DR severity per modified Davis staging, retinal fundus photograph, NIDEK AFC-230, 848 by 848 pixels, 45 degree fundus photograph:
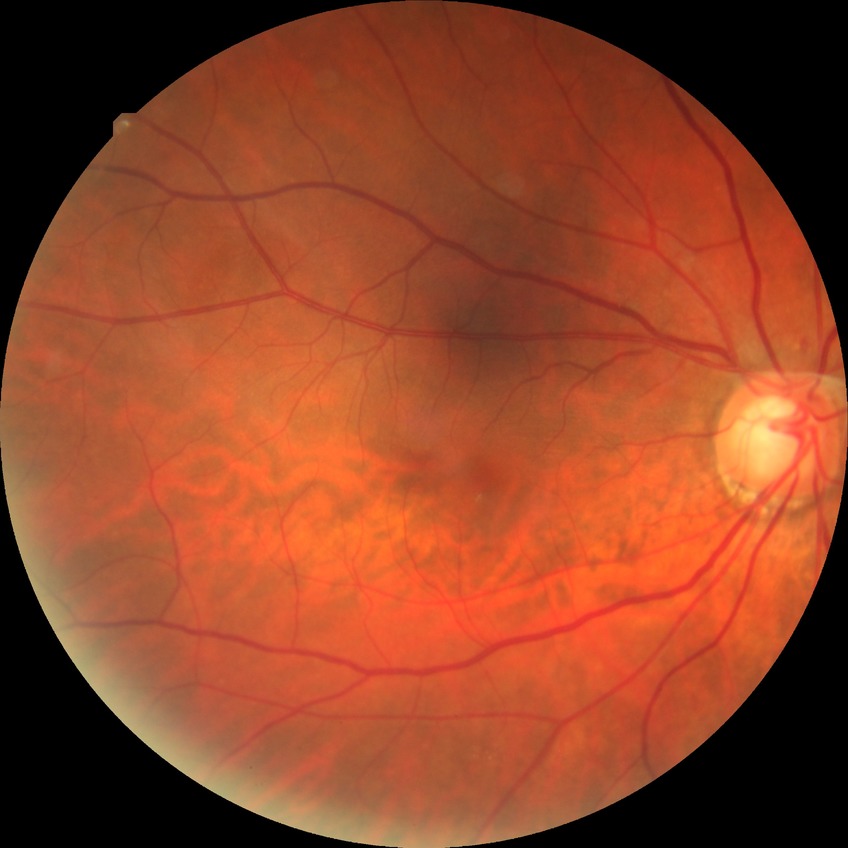

DR stage: NDR. No signs of diabetic retinopathy.